Fundus photo; 45 degree fundus photograph:
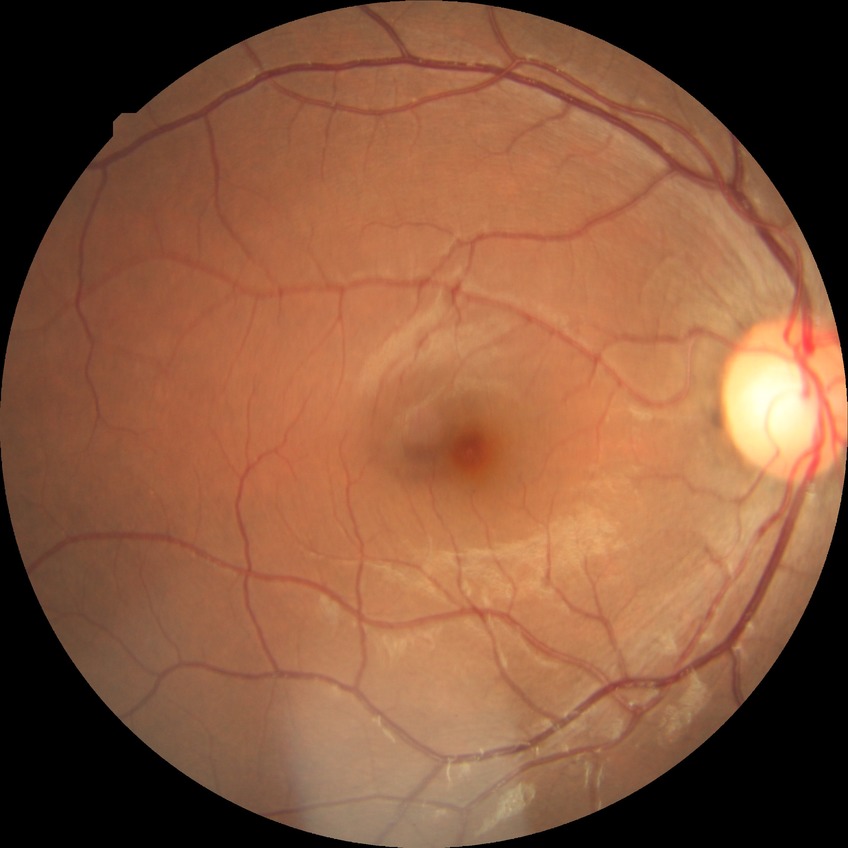 diabetic retinopathy (DR): no diabetic retinopathy (NDR).